Wide-field fundus image from infant ROP screening; 1240x1240; 100° field of view (Phoenix ICON):
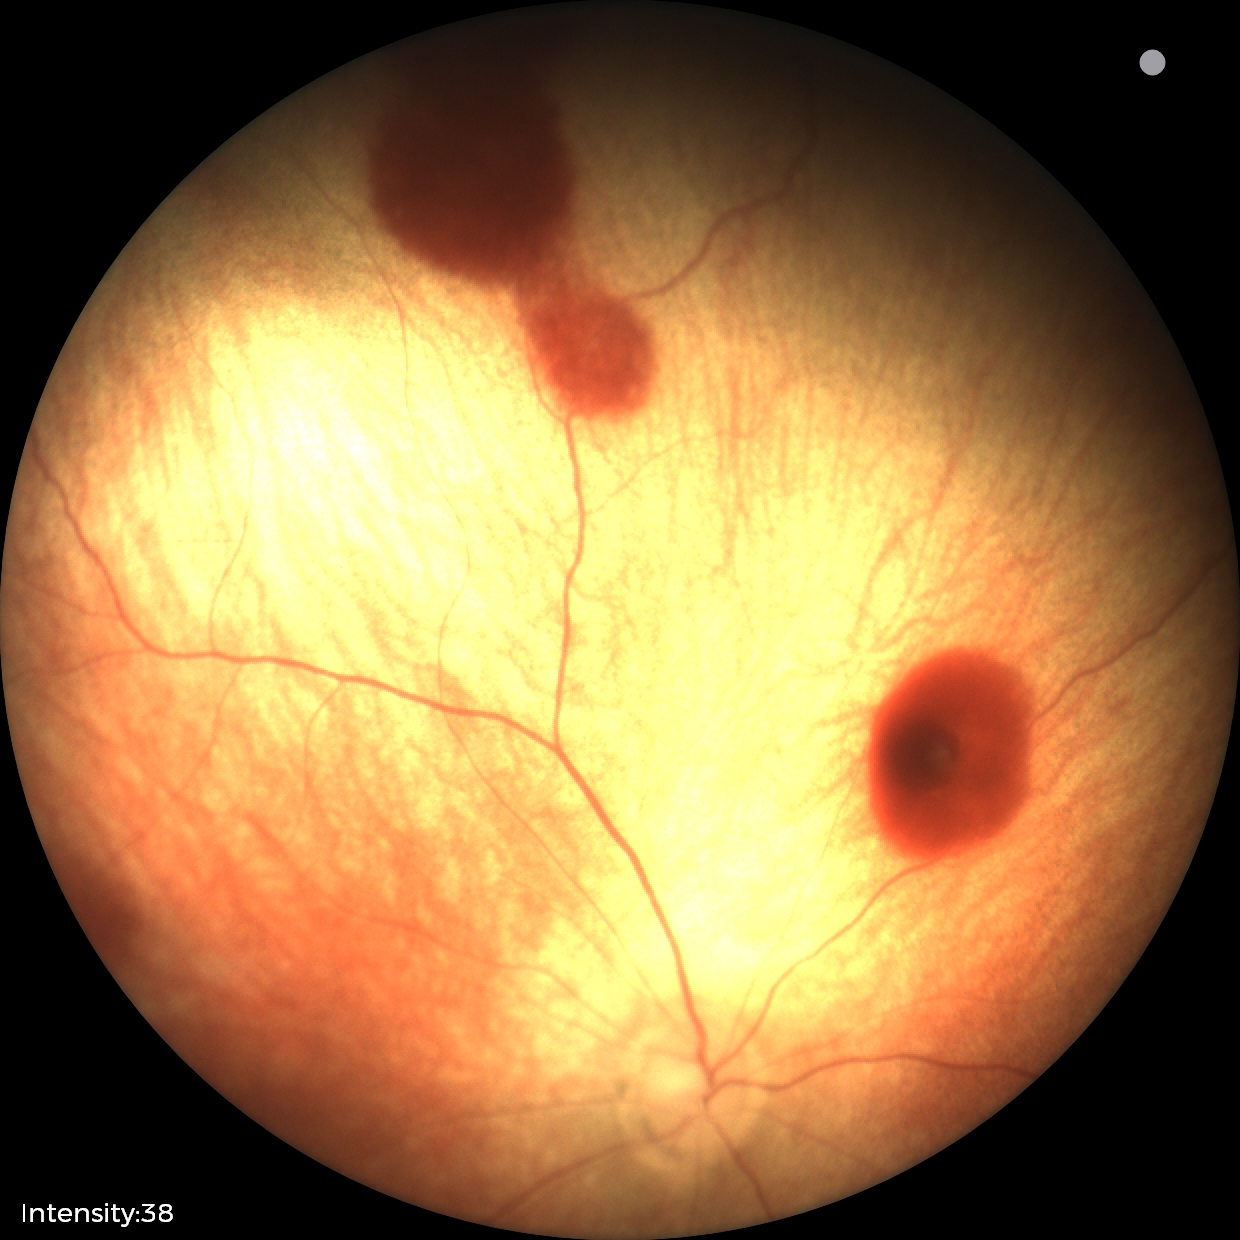 Impression: retinal hemorrhages.